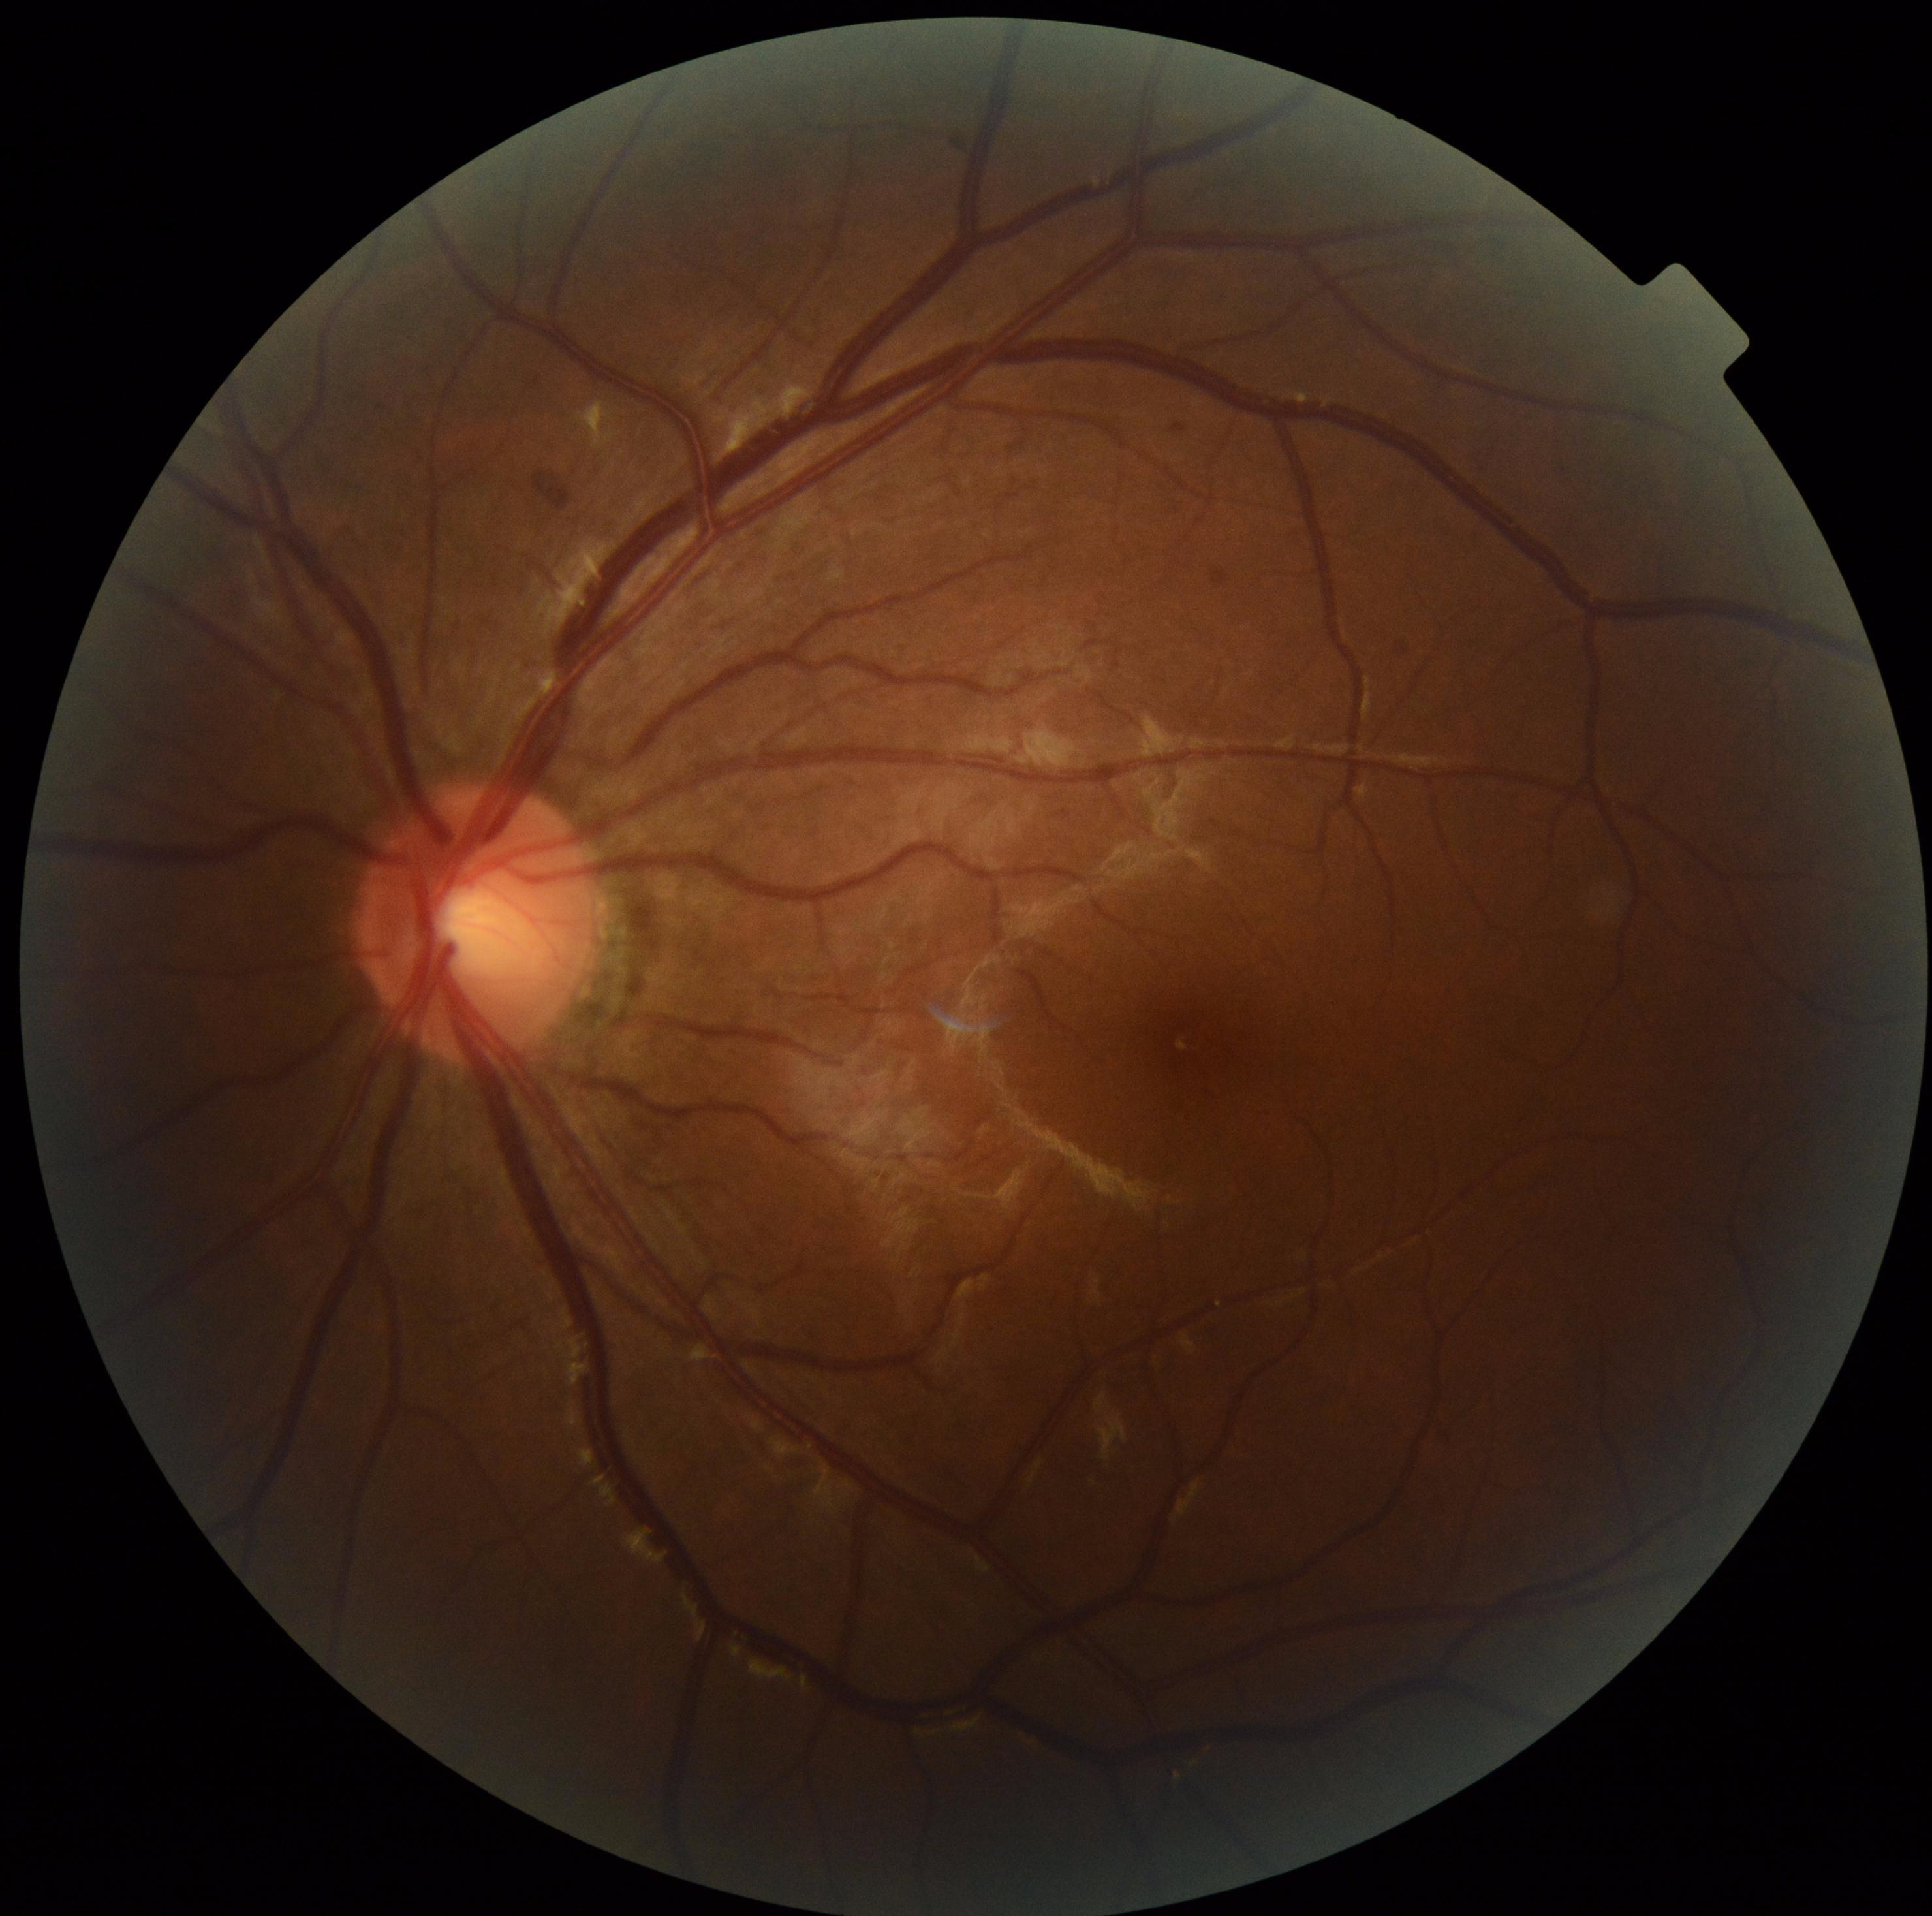

Retinopathy is moderate NPDR (grade 2). No soft exudates identified. No microaneurysms identified. No hard exudates identified. Hemorrhages present at bbox=(533, 474, 572, 513).